Retinal fundus photograph
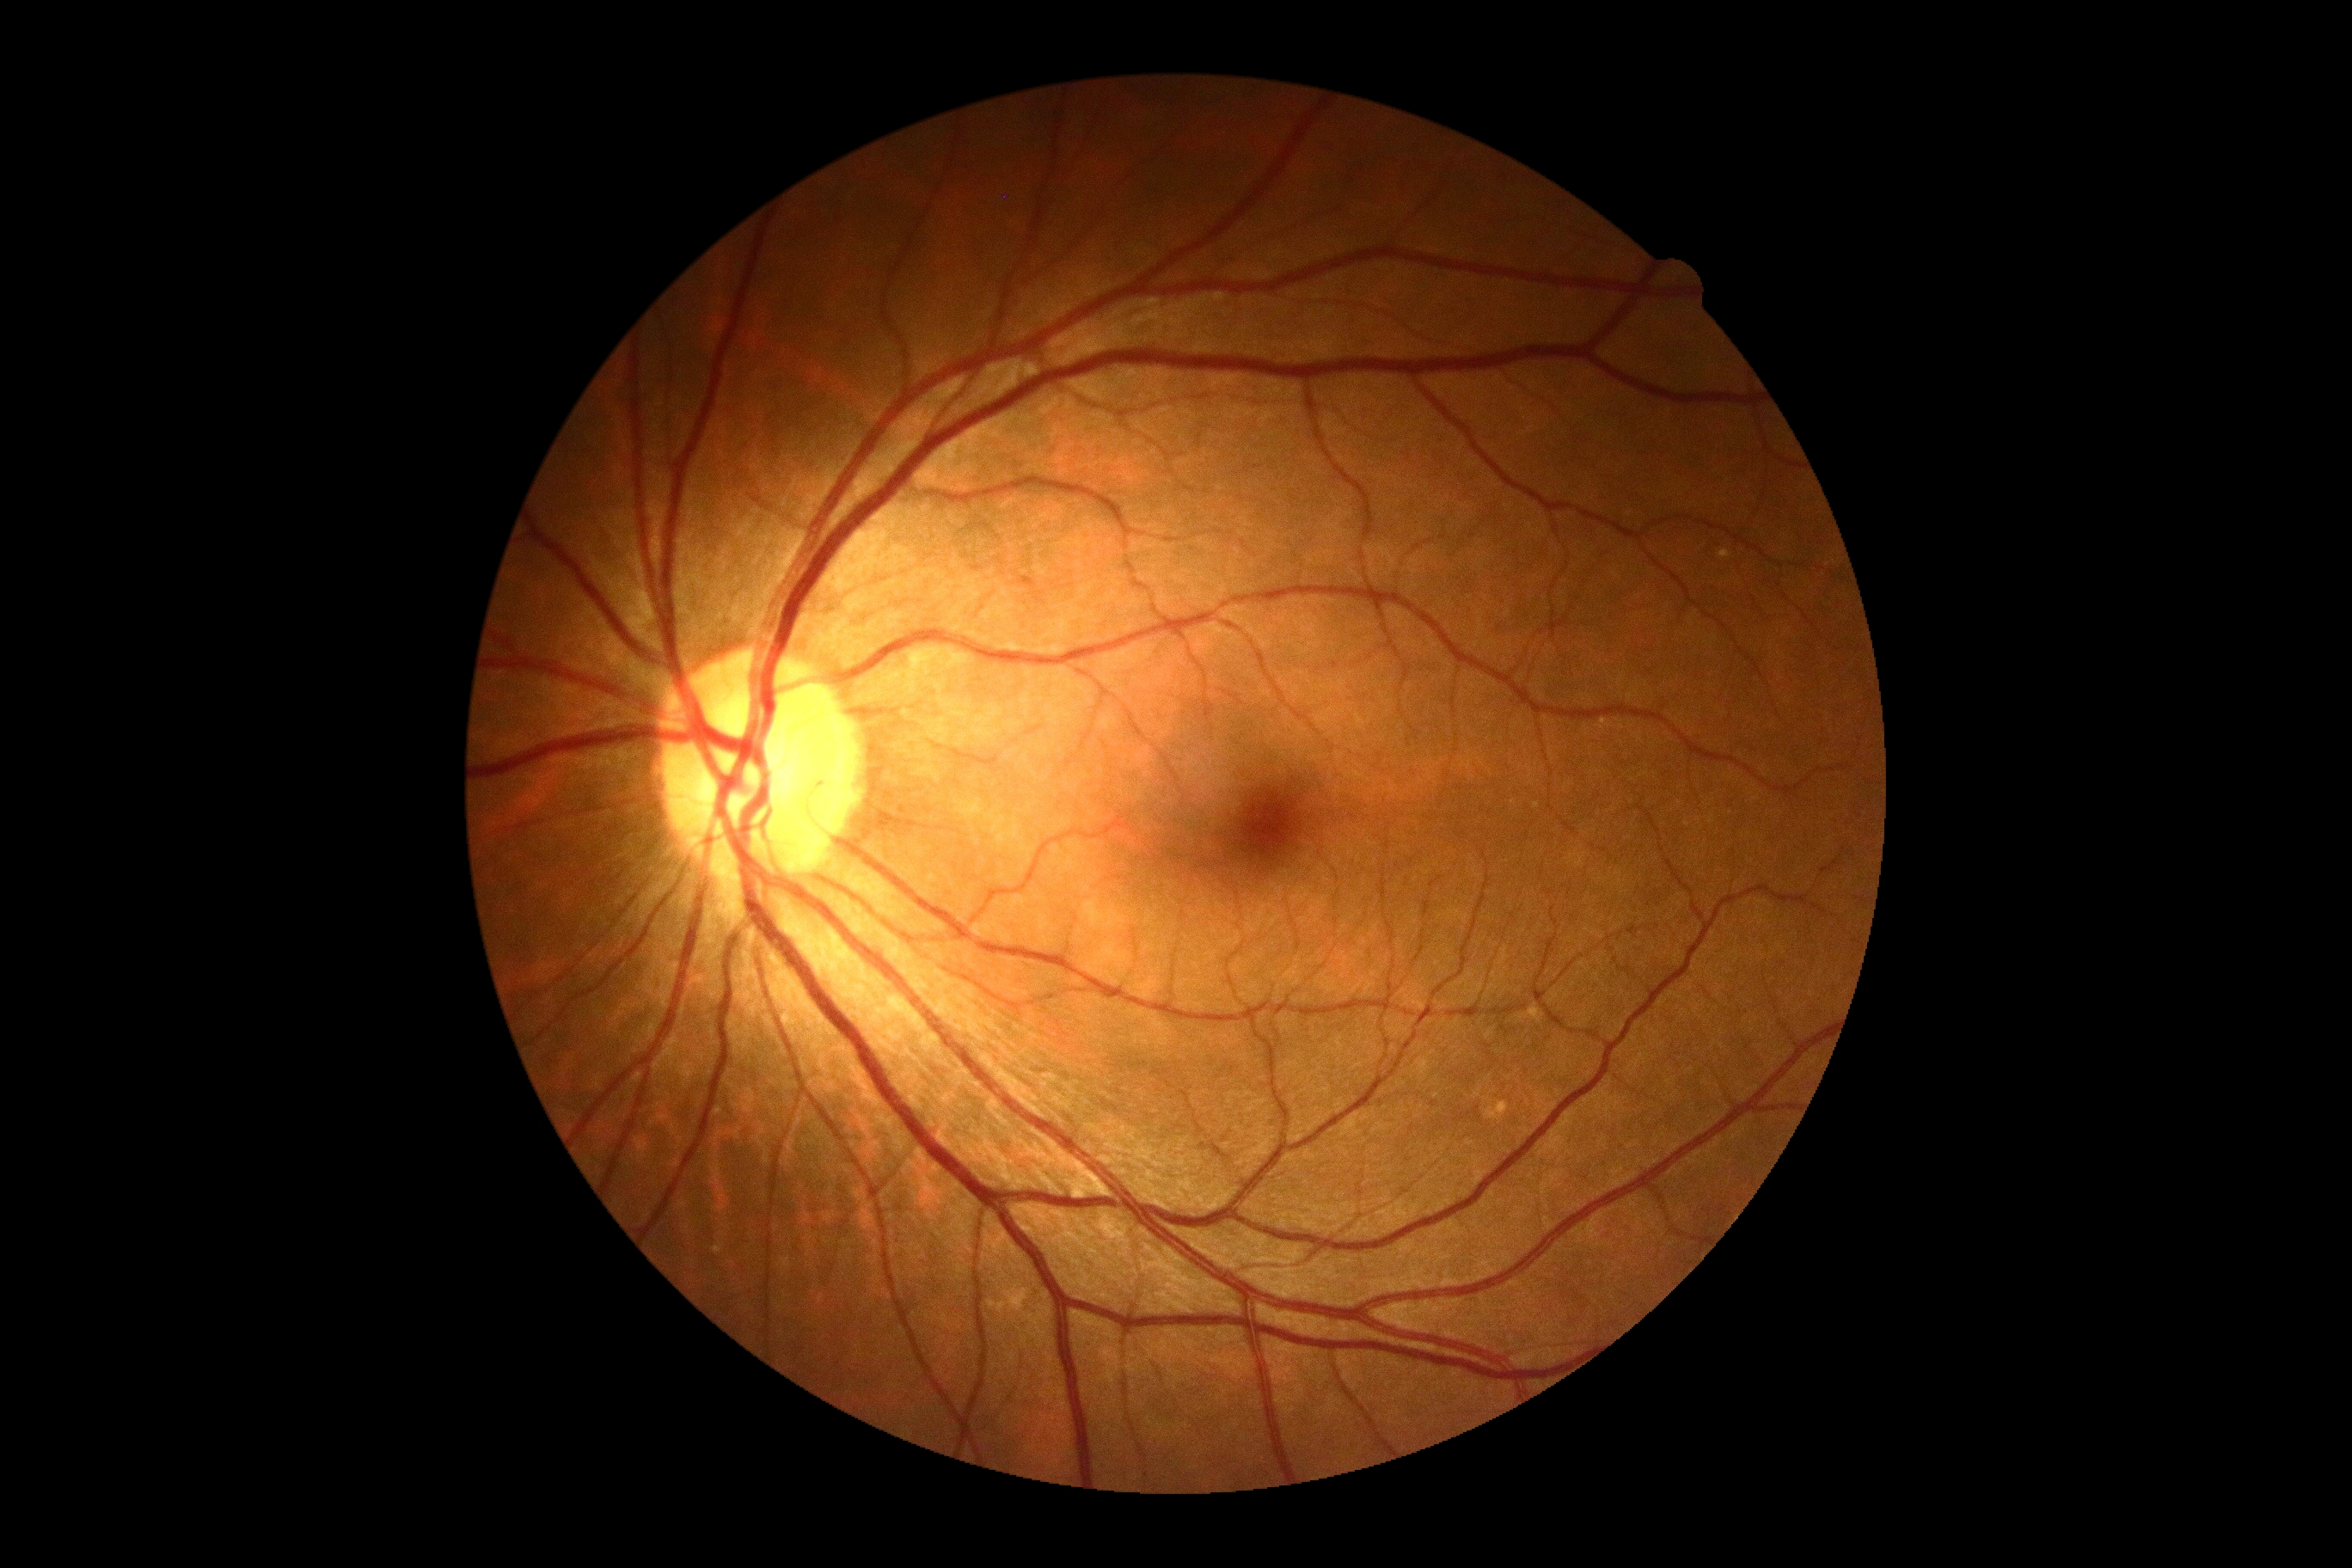 DR stage: 0/4.